Graded on the modified Davis scale; camera: NIDEK AFC-230 — 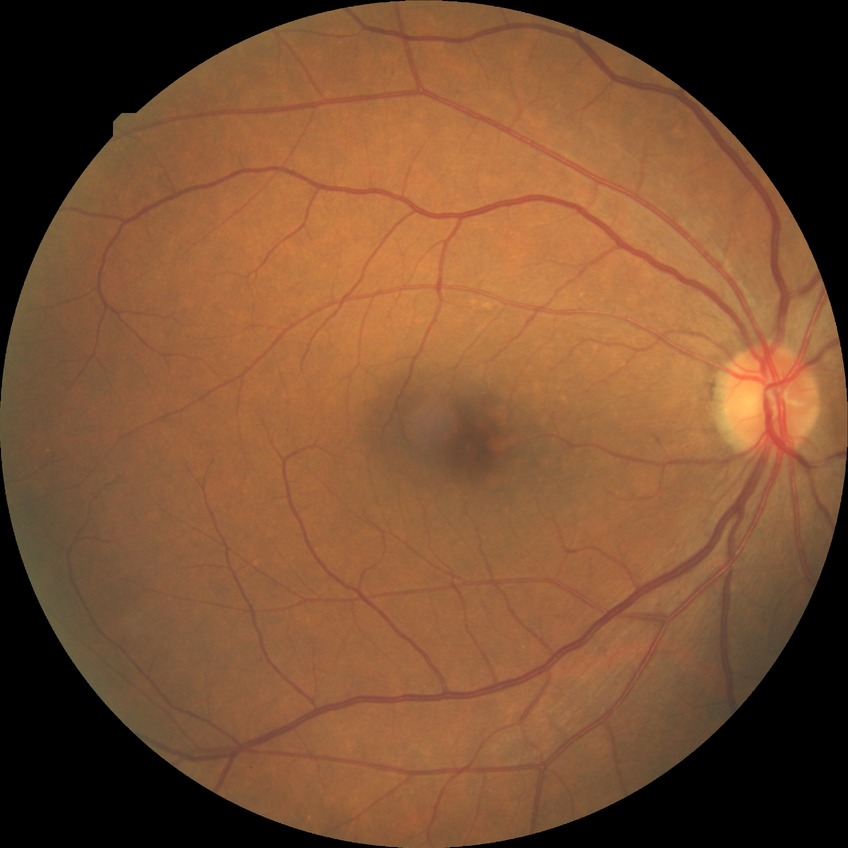

diabetic retinopathy (DR)@simple diabetic retinopathy (SDR).